NIDEK AFC-230 fundus camera: 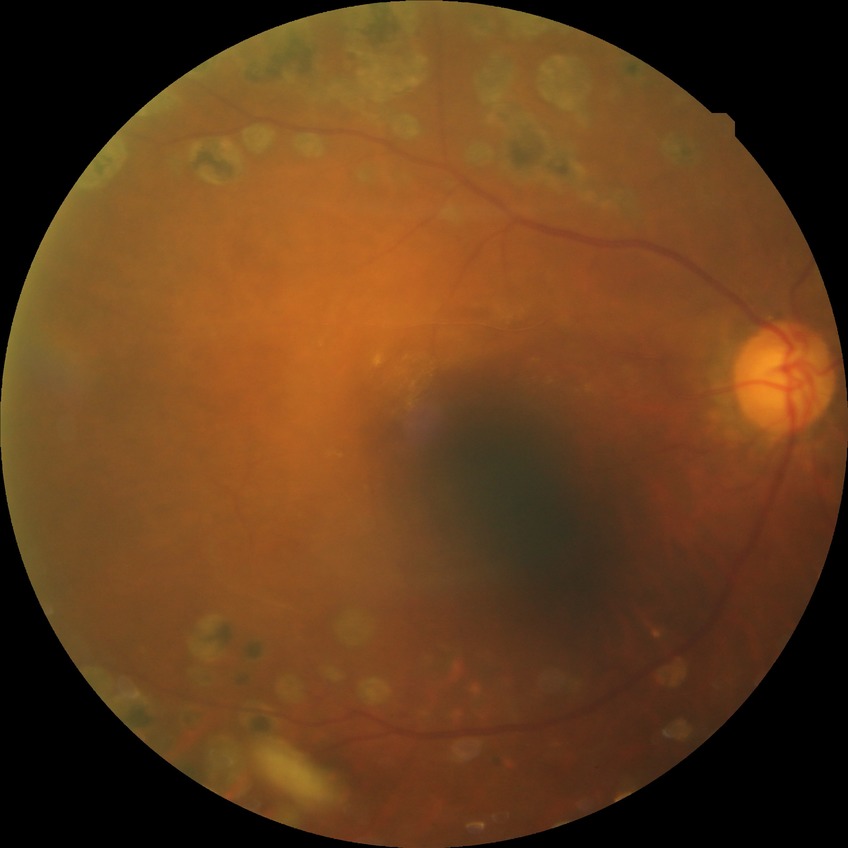

Modified Davis classification is proliferative diabetic retinopathy.